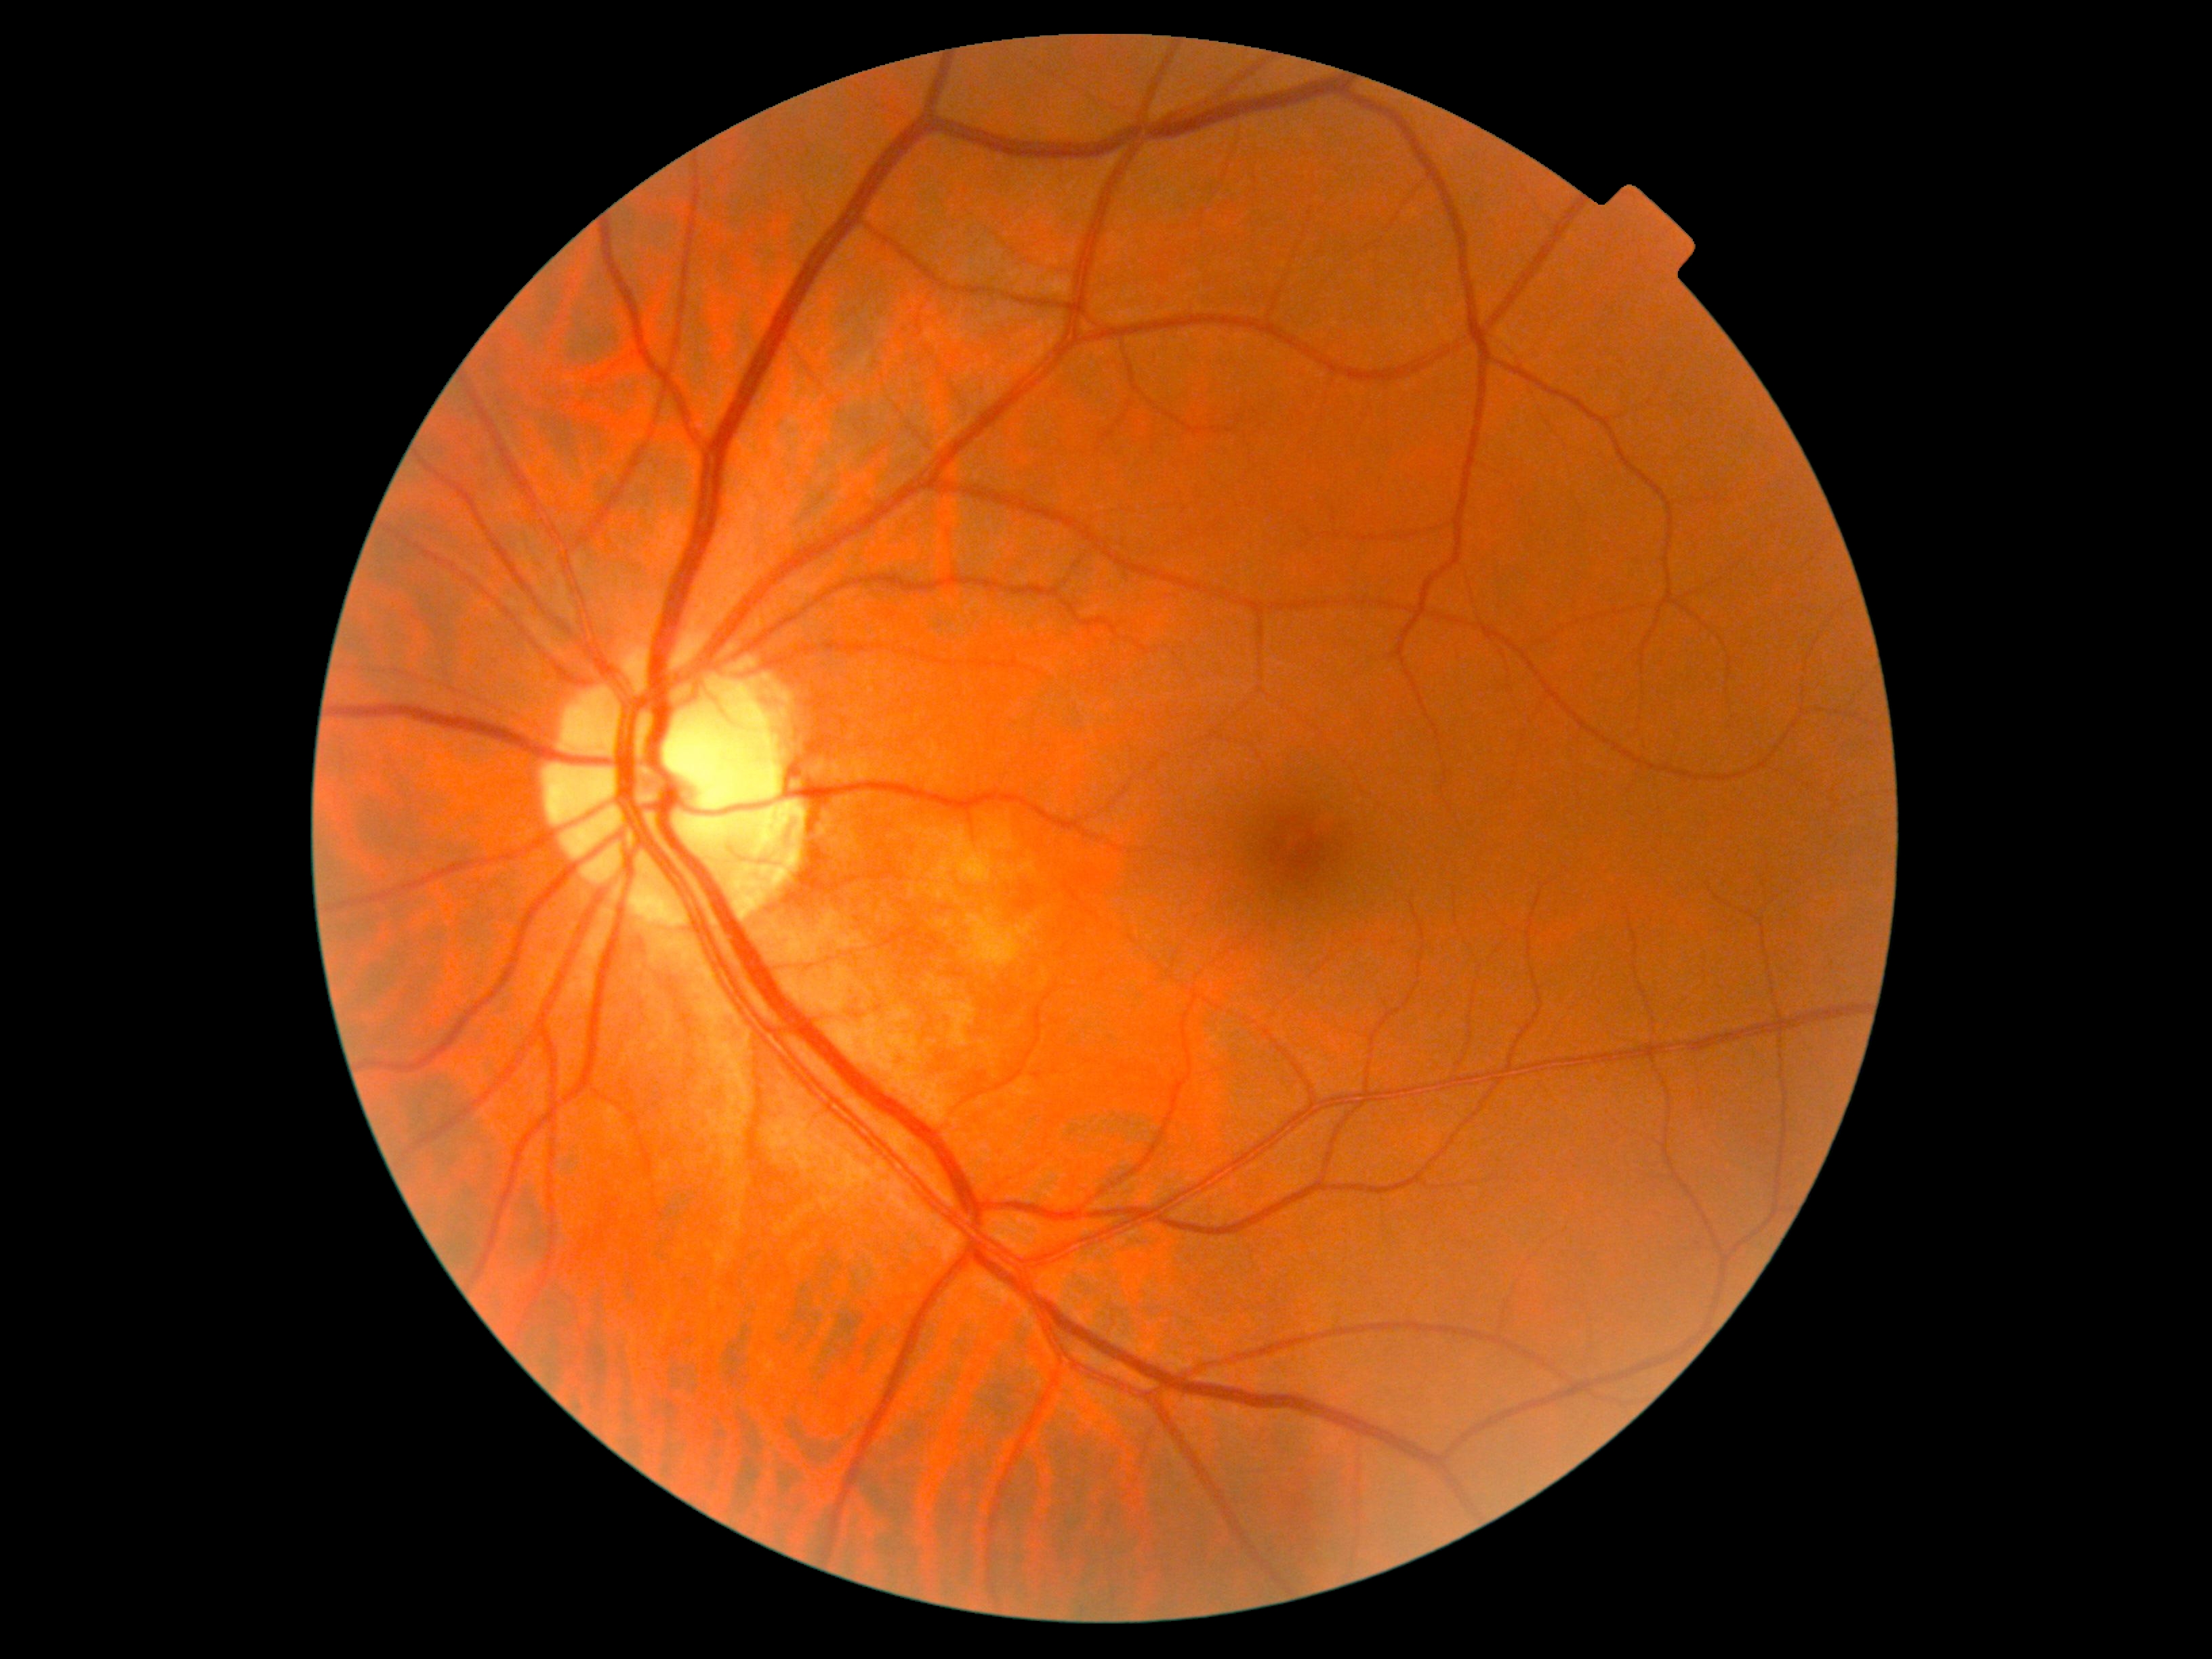

DR stage is no apparent retinopathy (grade 0).